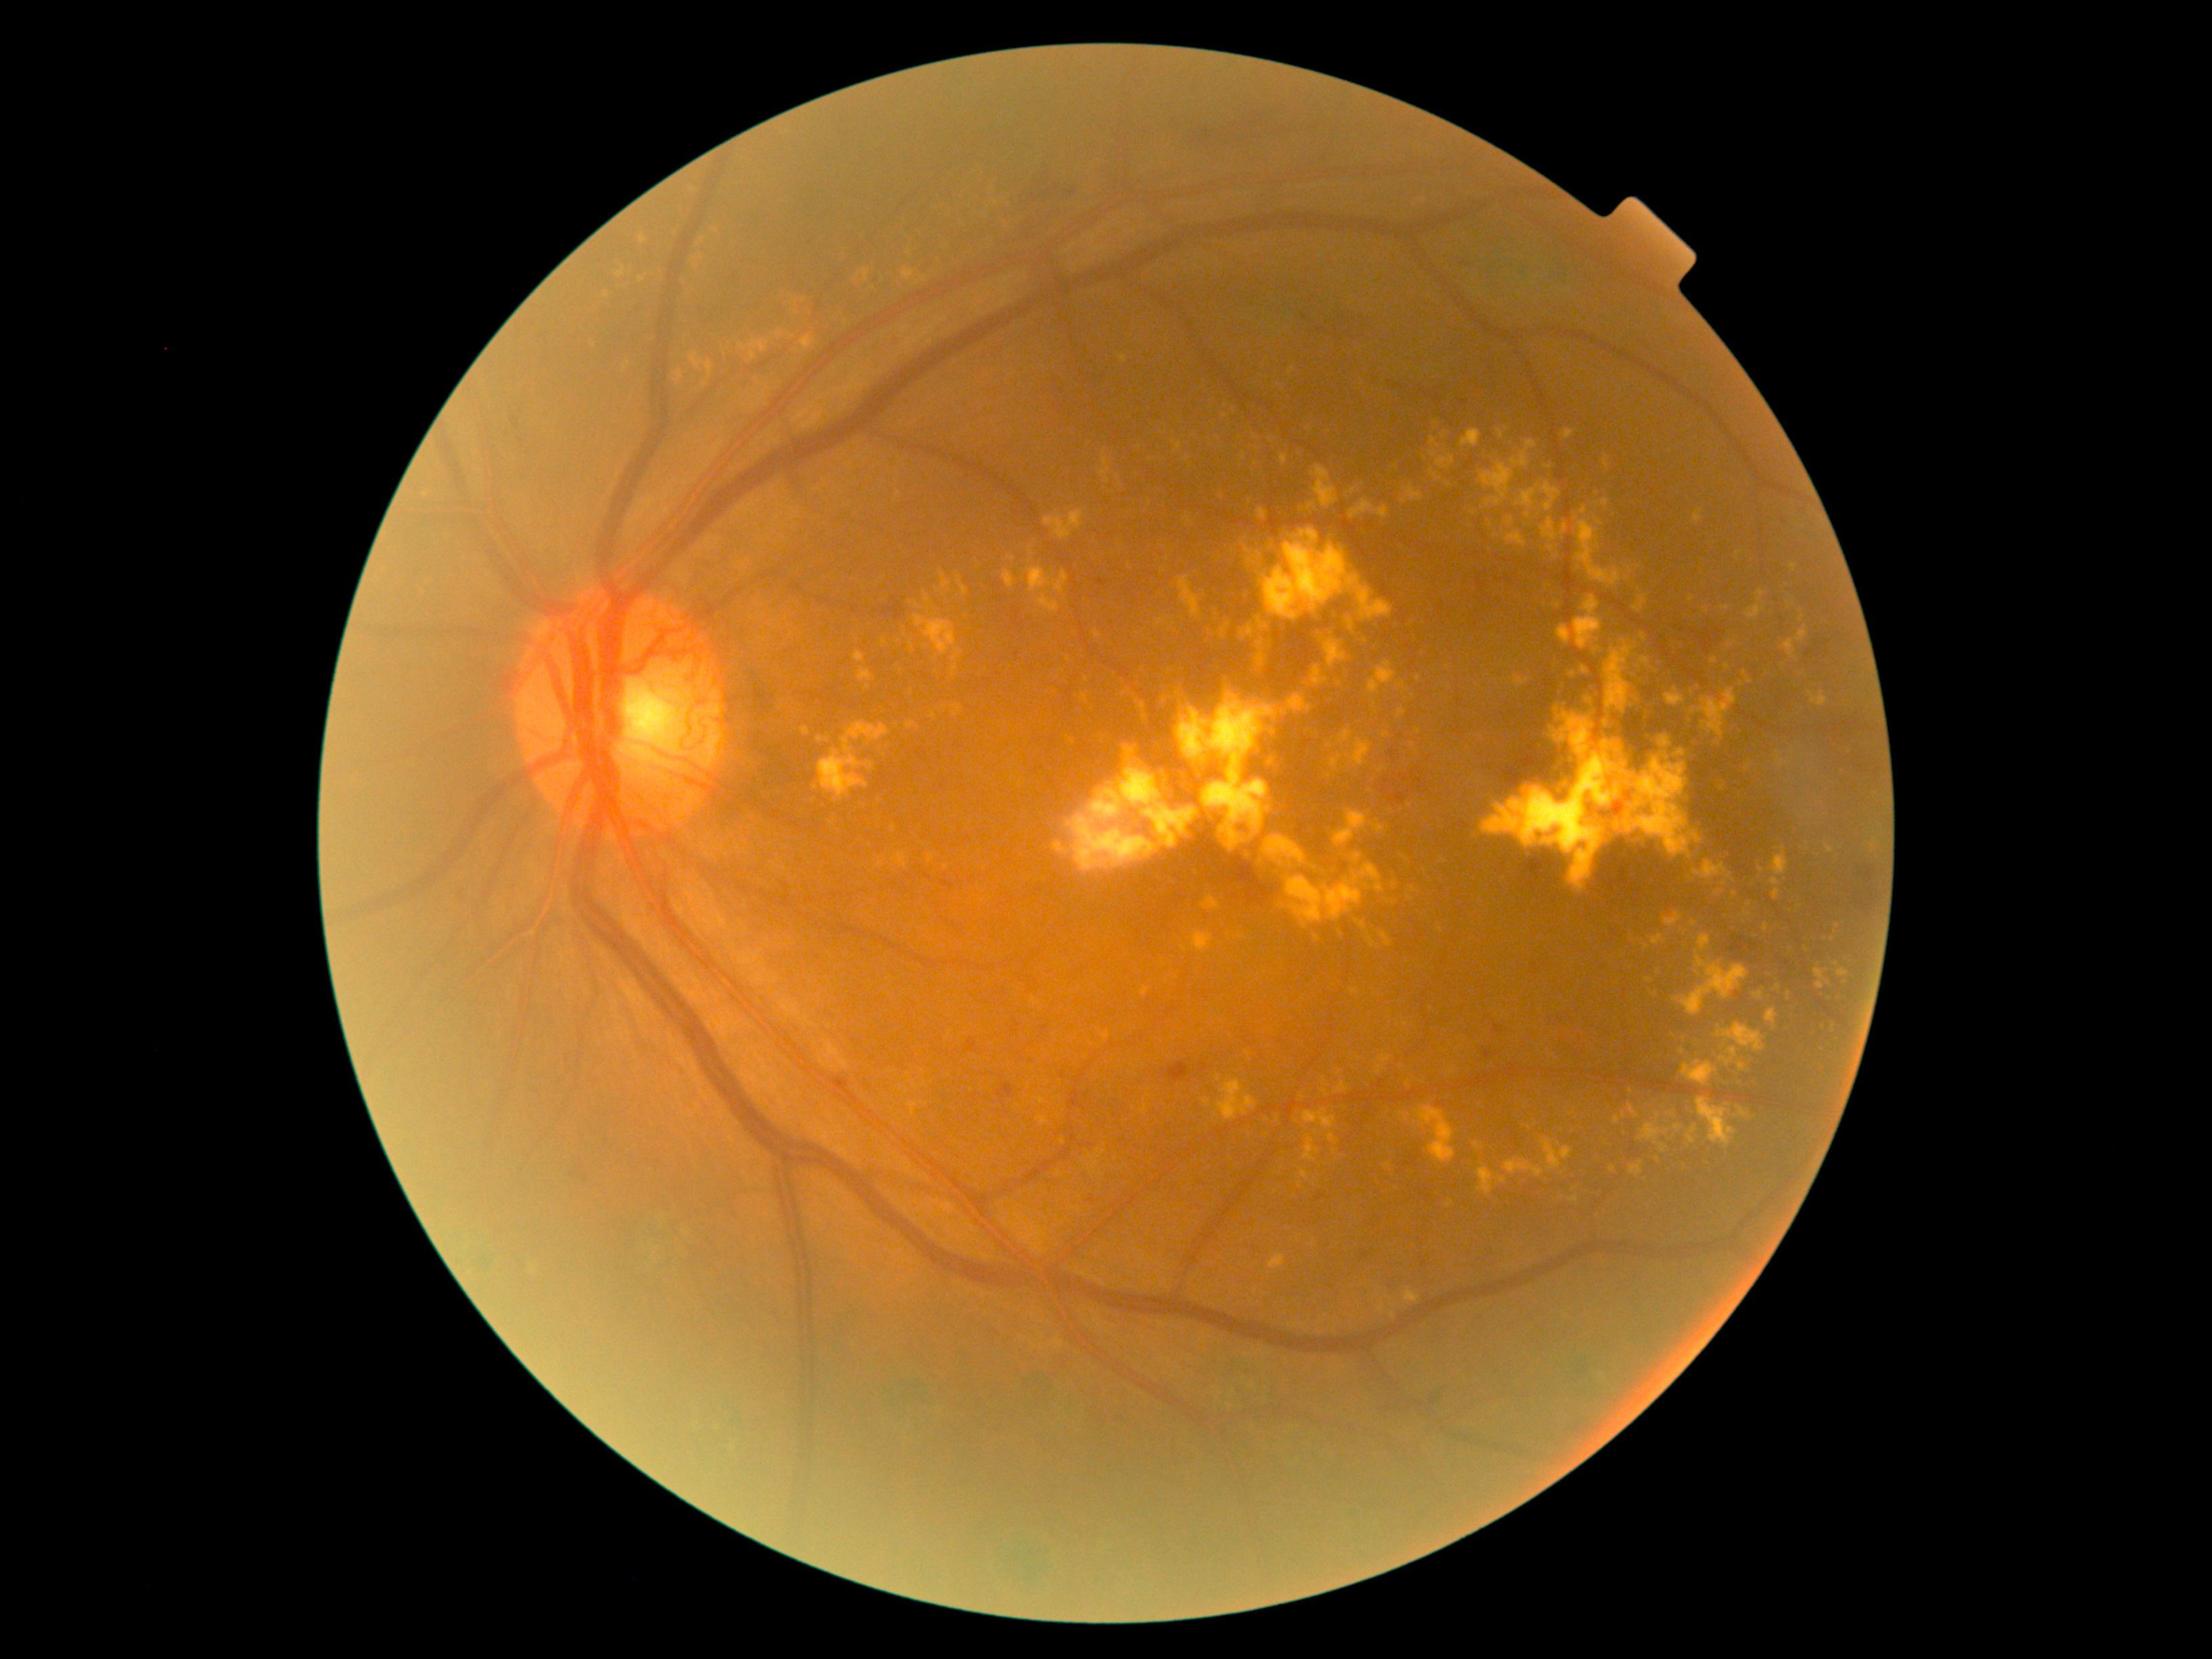 Diabetic retinopathy (DR) is PDR (grade 4) — neovascularization and/or vitreous/pre-retinal hemorrhage
Selected lesions:
- hard exudates (EXs) (continued): 1253, 636, 1272, 668 | 1570, 1196, 1578, 1202 | 1774, 642, 1779, 654 | 1370, 939, 1376, 947 | 1329, 738, 1372, 769 | 674, 371, 682, 386 | 1340, 853, 1348, 863 | 1123, 689, 1135, 697 | 1816, 968, 1830, 990 | 1429, 468, 1441, 482 | 791, 296, 806, 311 | 1263, 529, 1393, 620
- Additional small EXs near 1291:371 | 1227:416 | 1410:805 | 1723:1082 | 933:716 | 831:824 | 1184:948 | 629:364